Ultra-widefield fundus photograph.
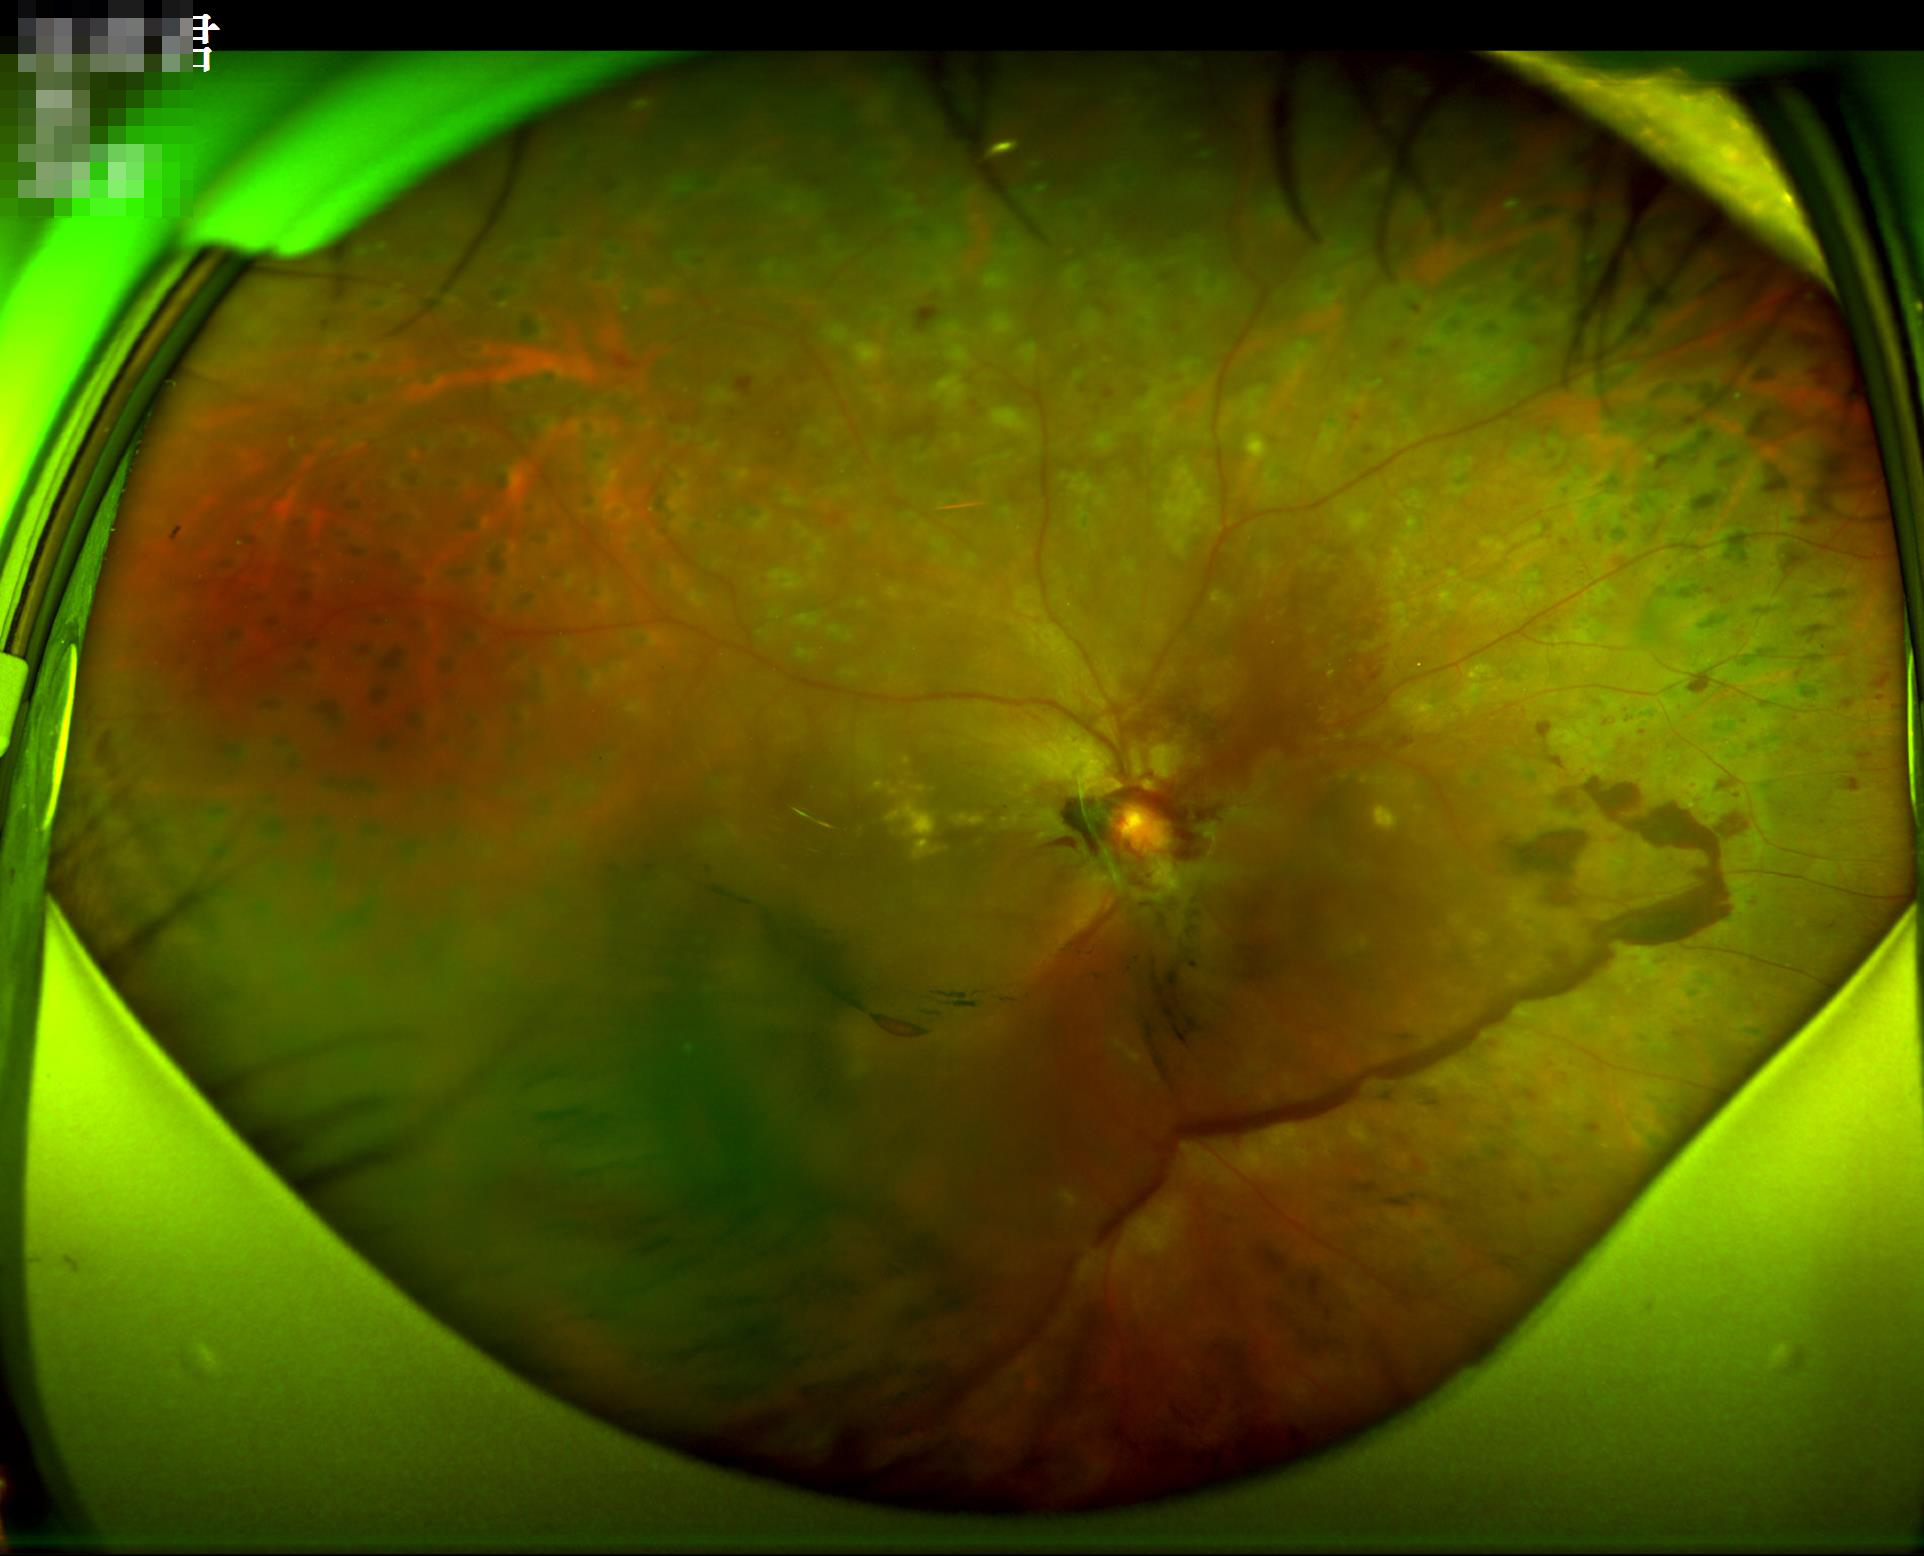

Clarity: noticeable blur in the optic disc, vessels, or background
Overall: inadequate for clinical interpretation
Illumination/color: over- or under-exposed